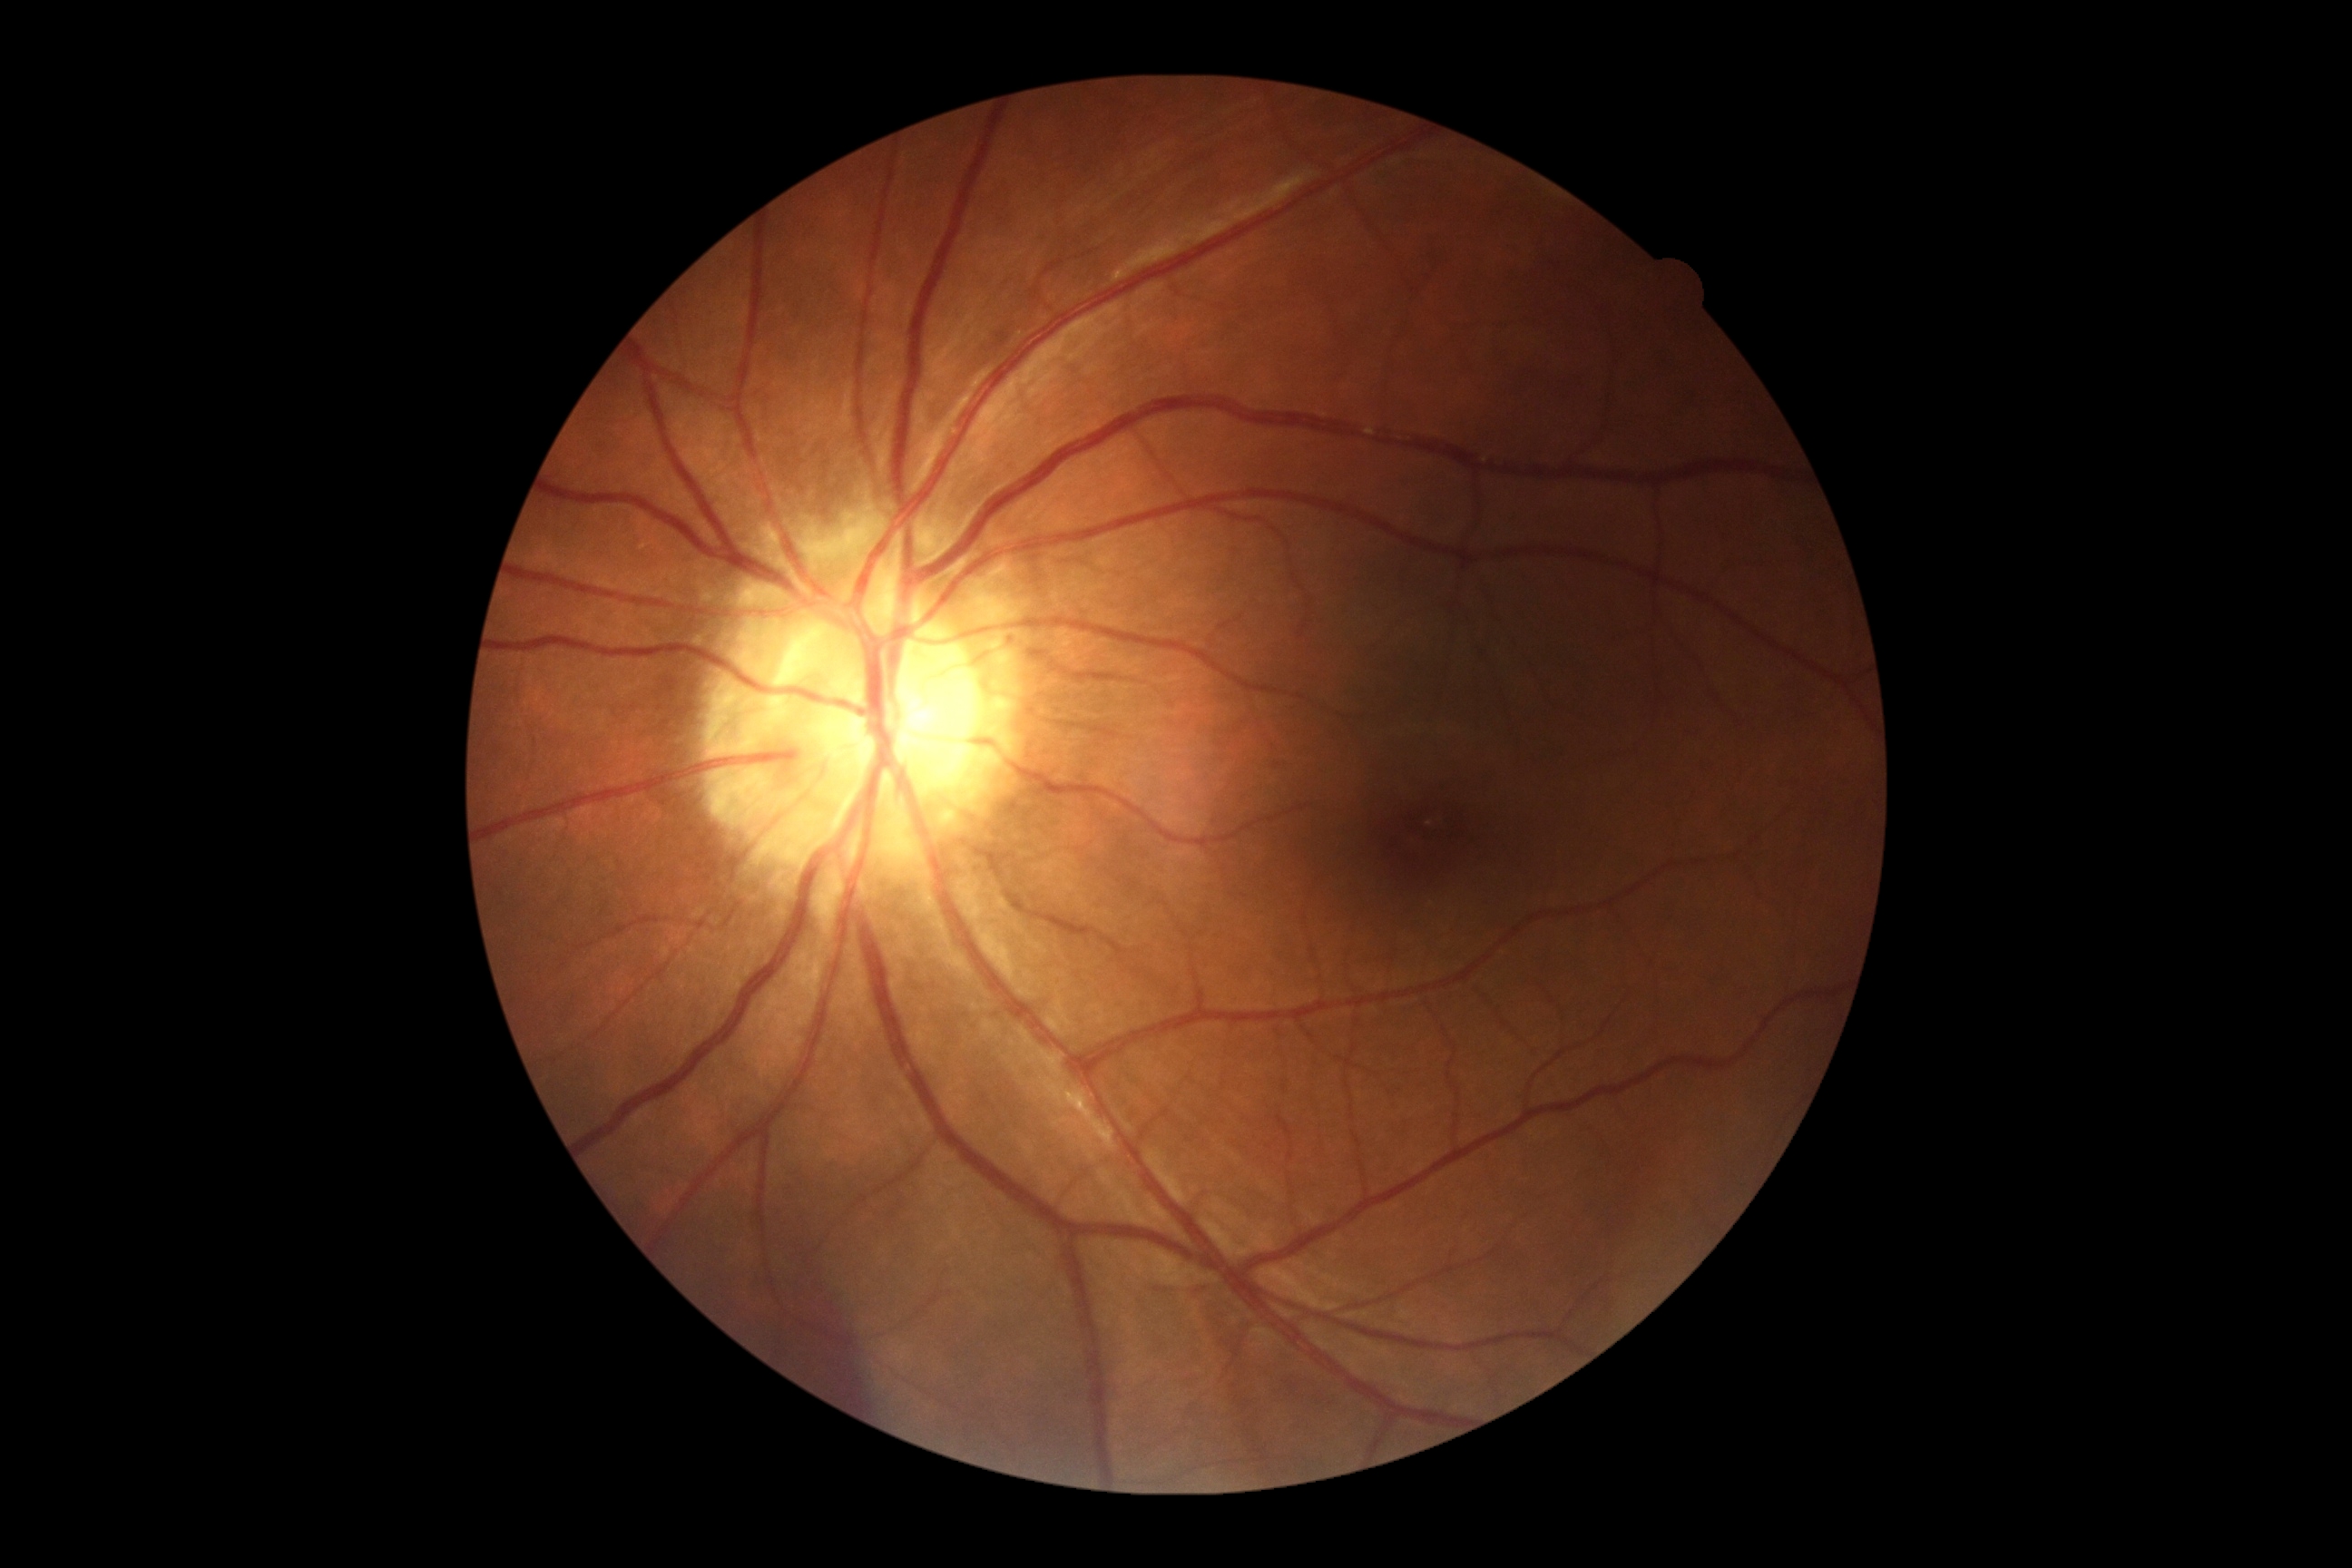
Retinopathy grade: 0 (no apparent retinopathy) — no visible signs of diabetic retinopathy.